640x480px · pediatric wide-field fundus photograph · 130° field of view (Clarity RetCam 3)
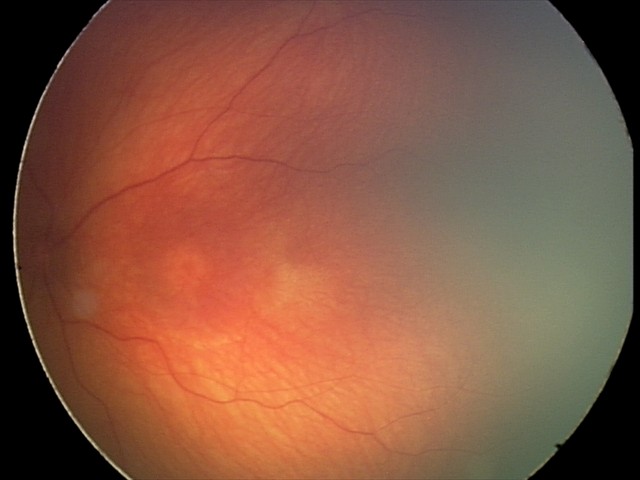

Assessment: no abnormal retinal findings.